Portable fundus camera image.
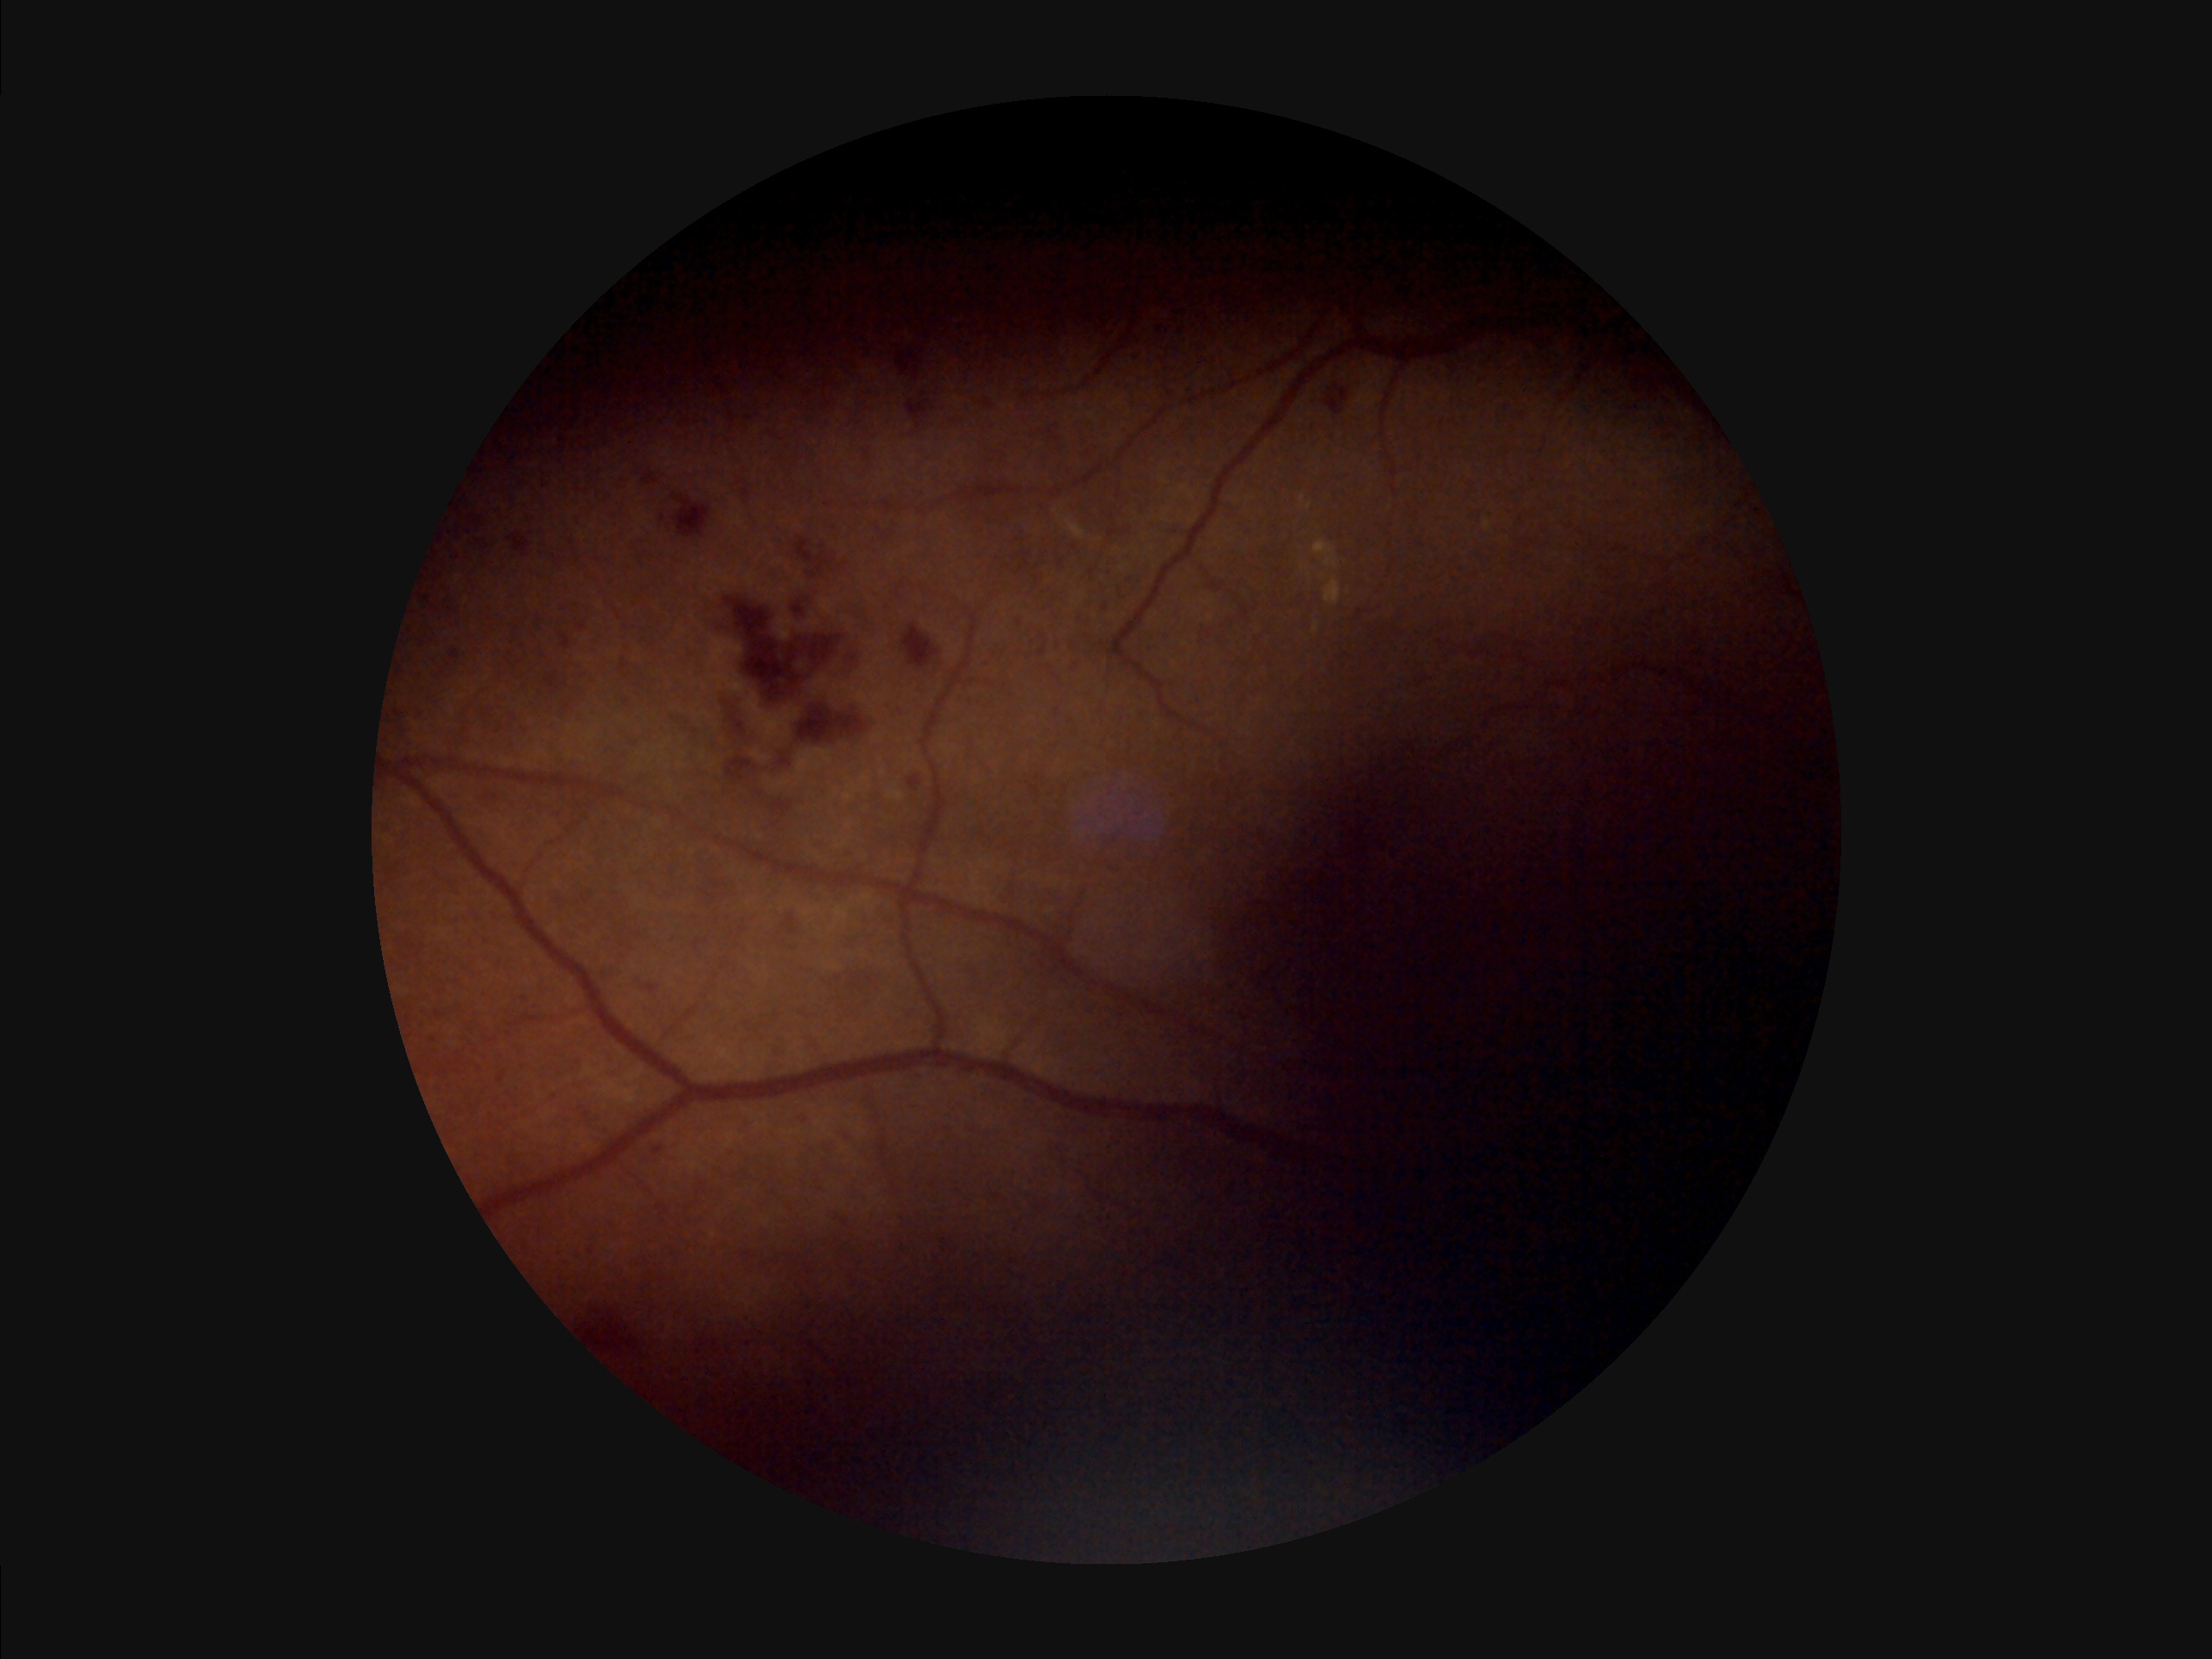

Vessels and details are hard to distinguish.
Illumination and color are suboptimal.
Overall quality is poor; the image is difficult to grade.